Non-mydriatic:
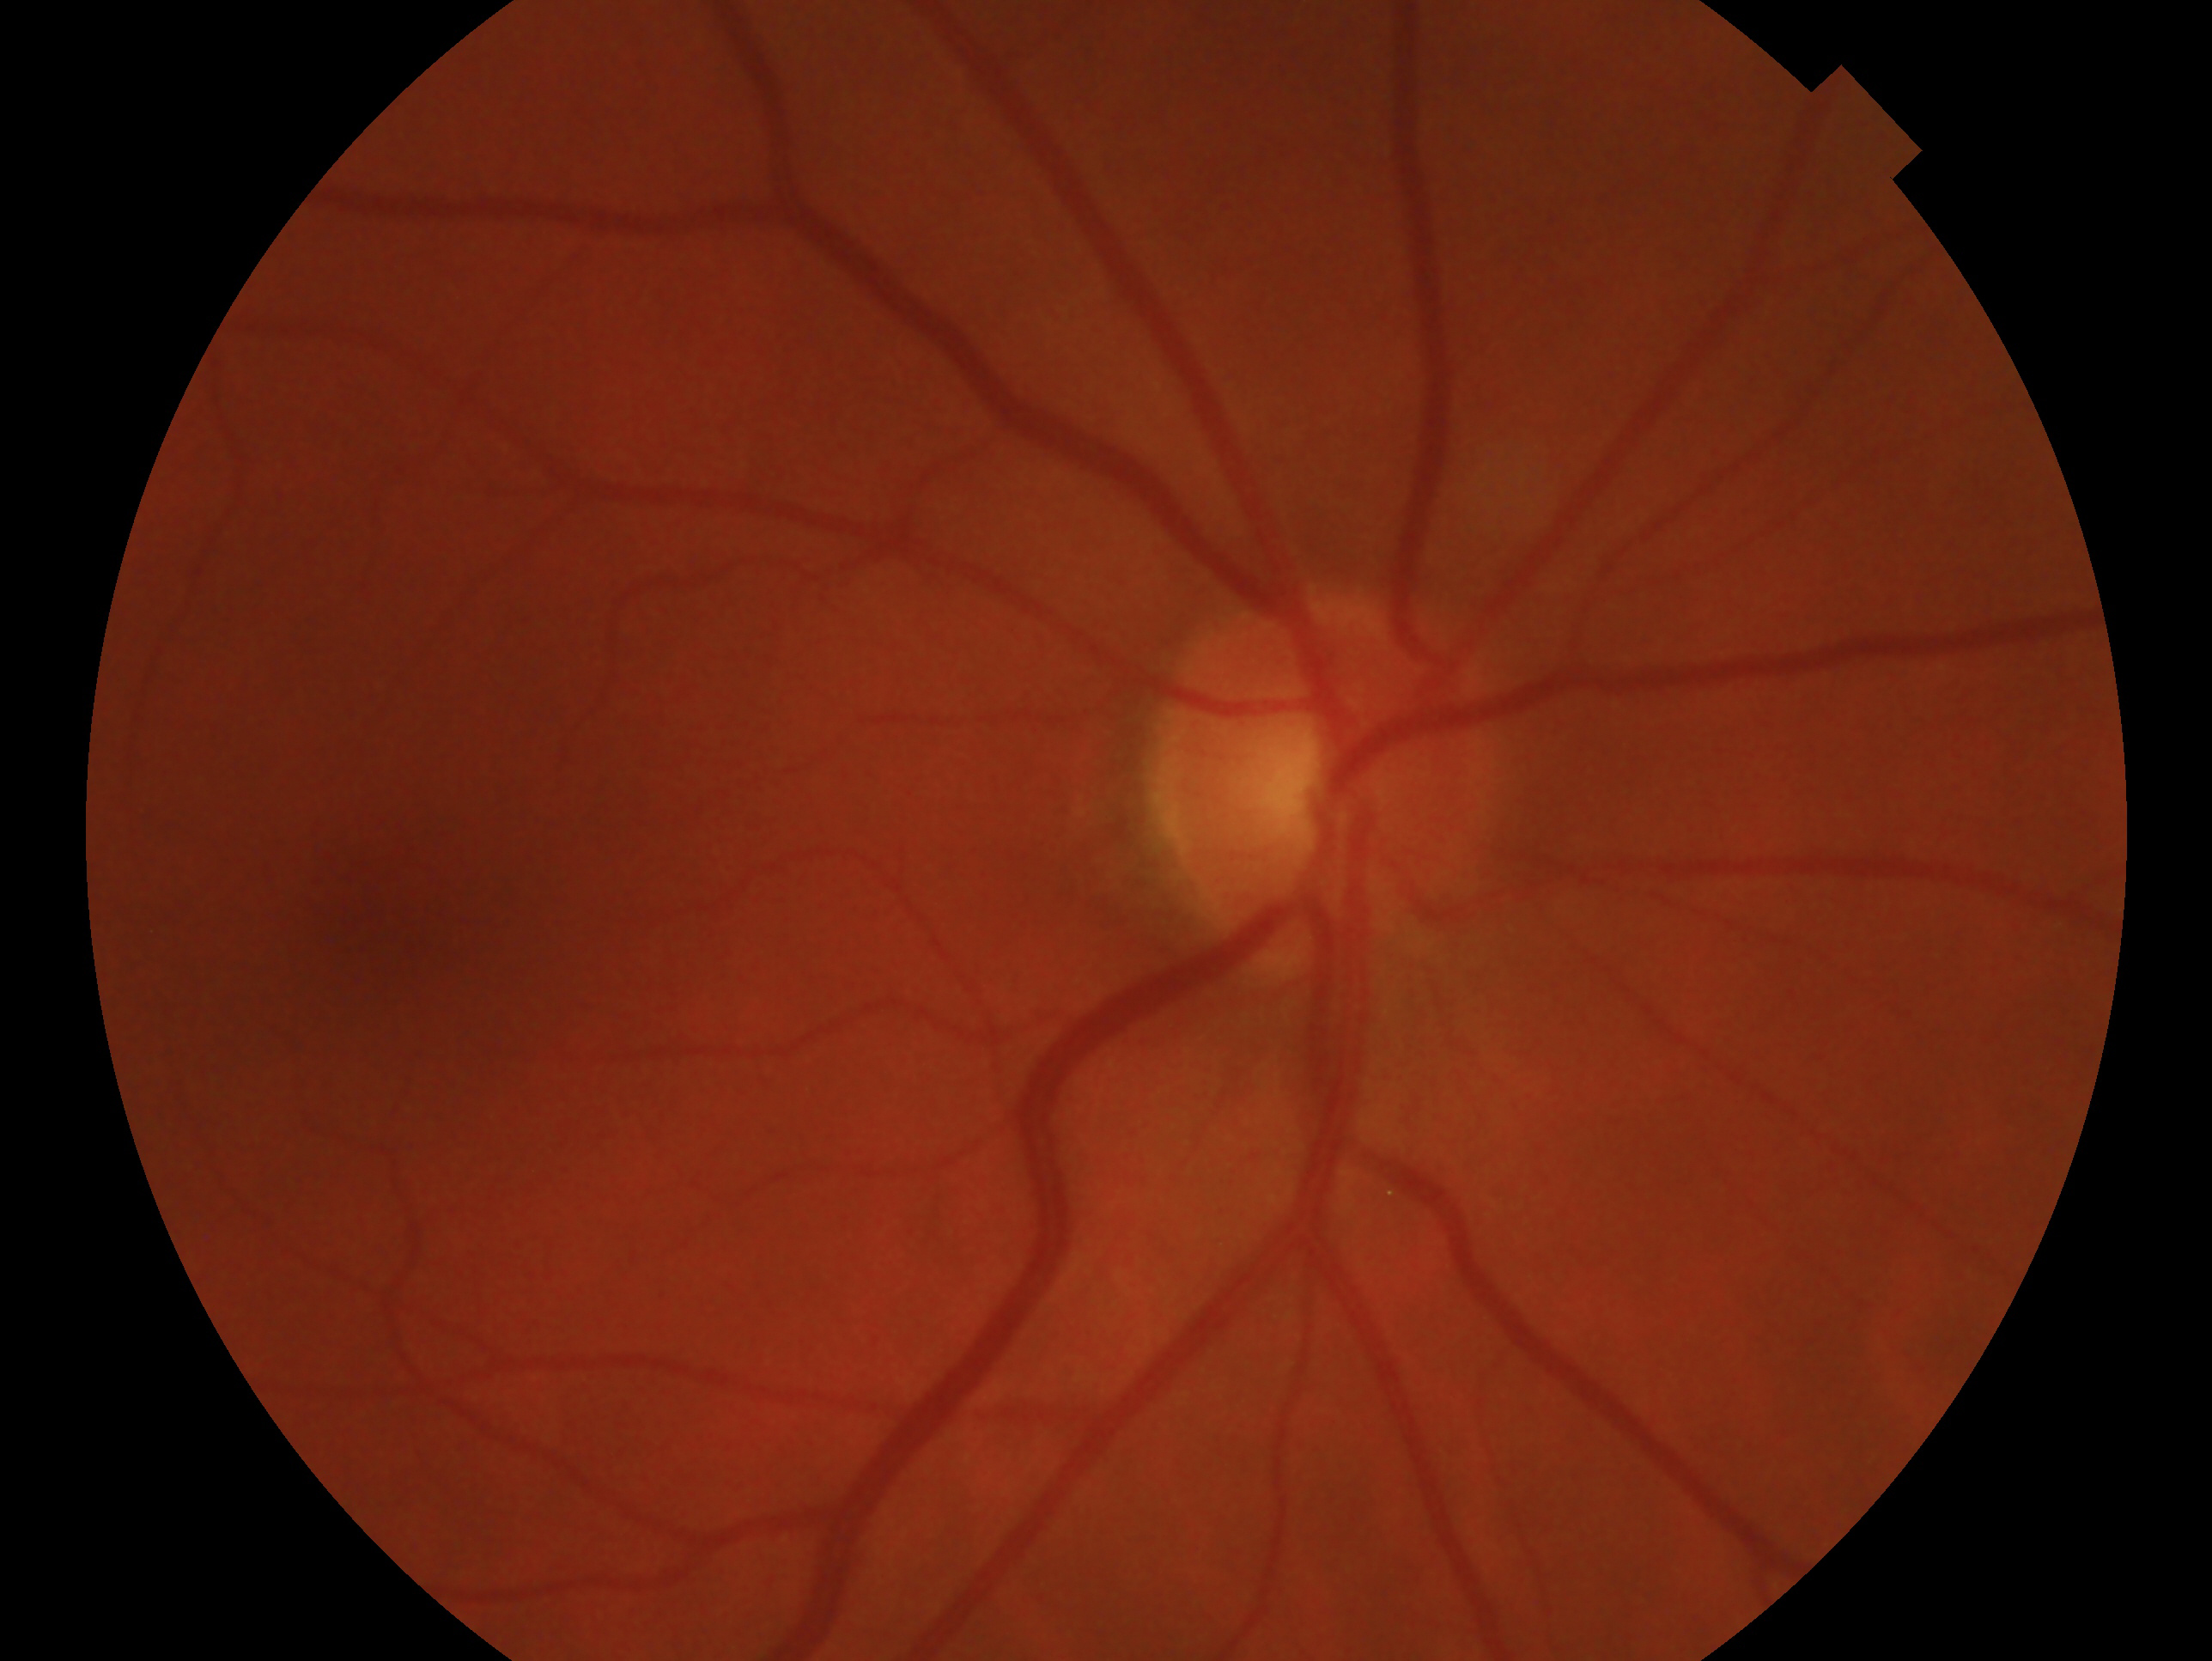 laterality = oculus dexter | glaucoma status = no evidence of glaucoma.